Davis DR grading: 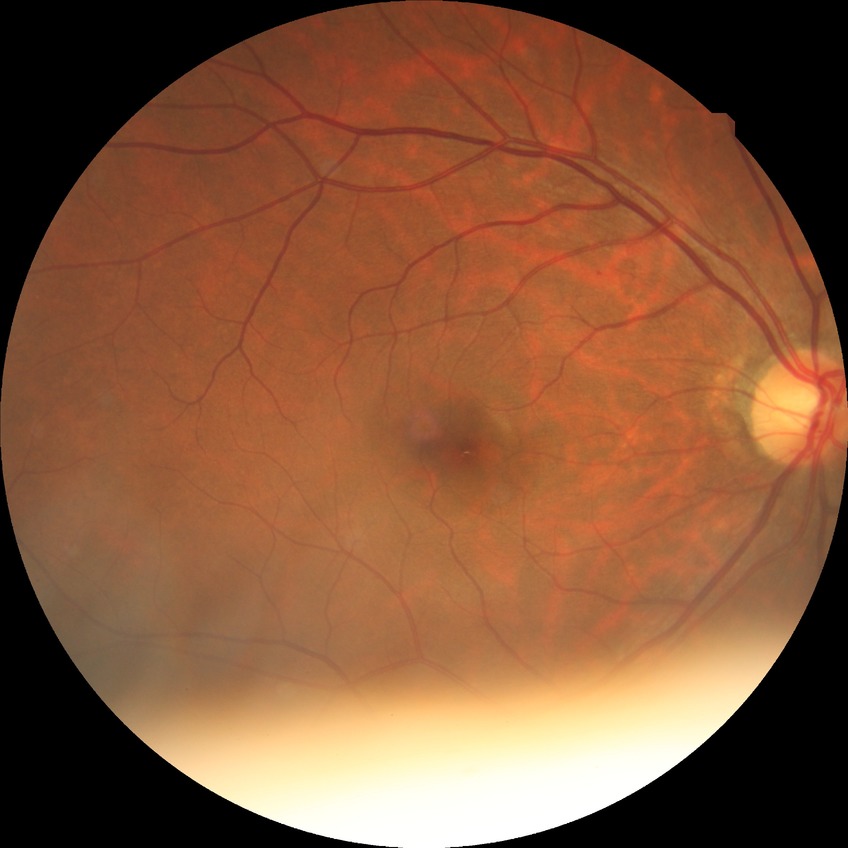 Retinopathy stage is no diabetic retinopathy.